Infant wide-field retinal image
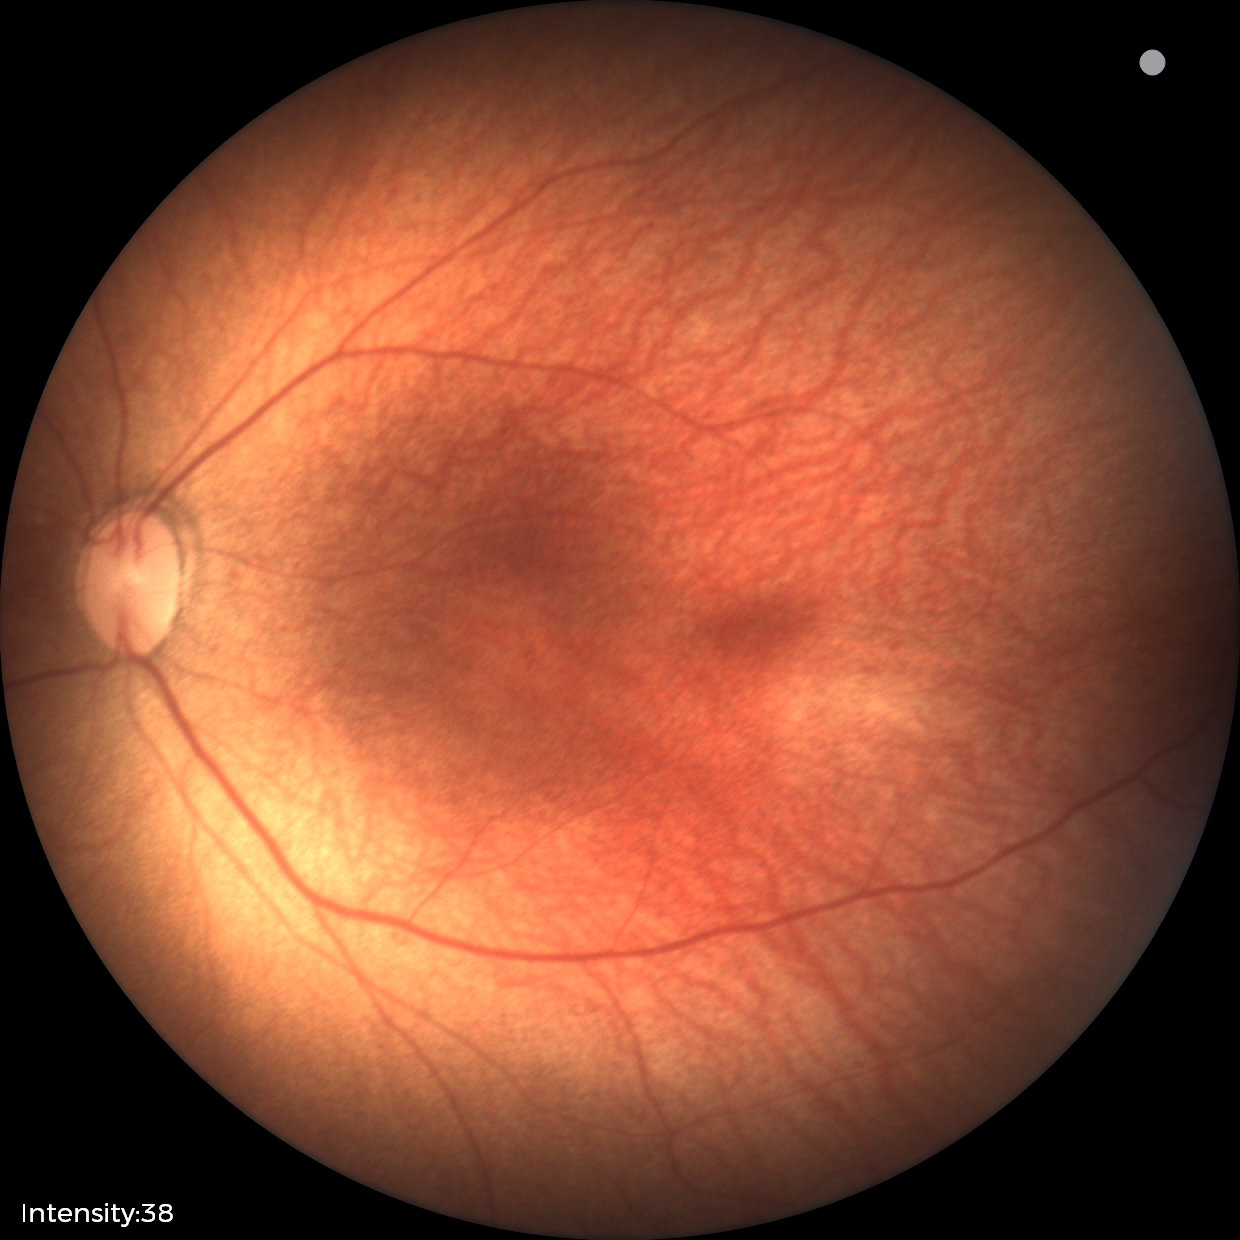 From an examination with diagnosis of status post retinopathy of prematurity.